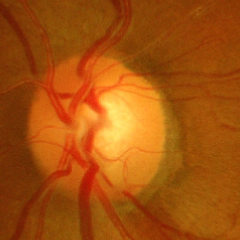
Glaucoma is present. Glaucoma status: advanced-stage glaucoma. Diagnostic criteria: near-total cupping of the optic nerve head, with or without severe visual field loss within the central 10 degrees of fixation.